Topcon TRC-50DX; fundus photo:
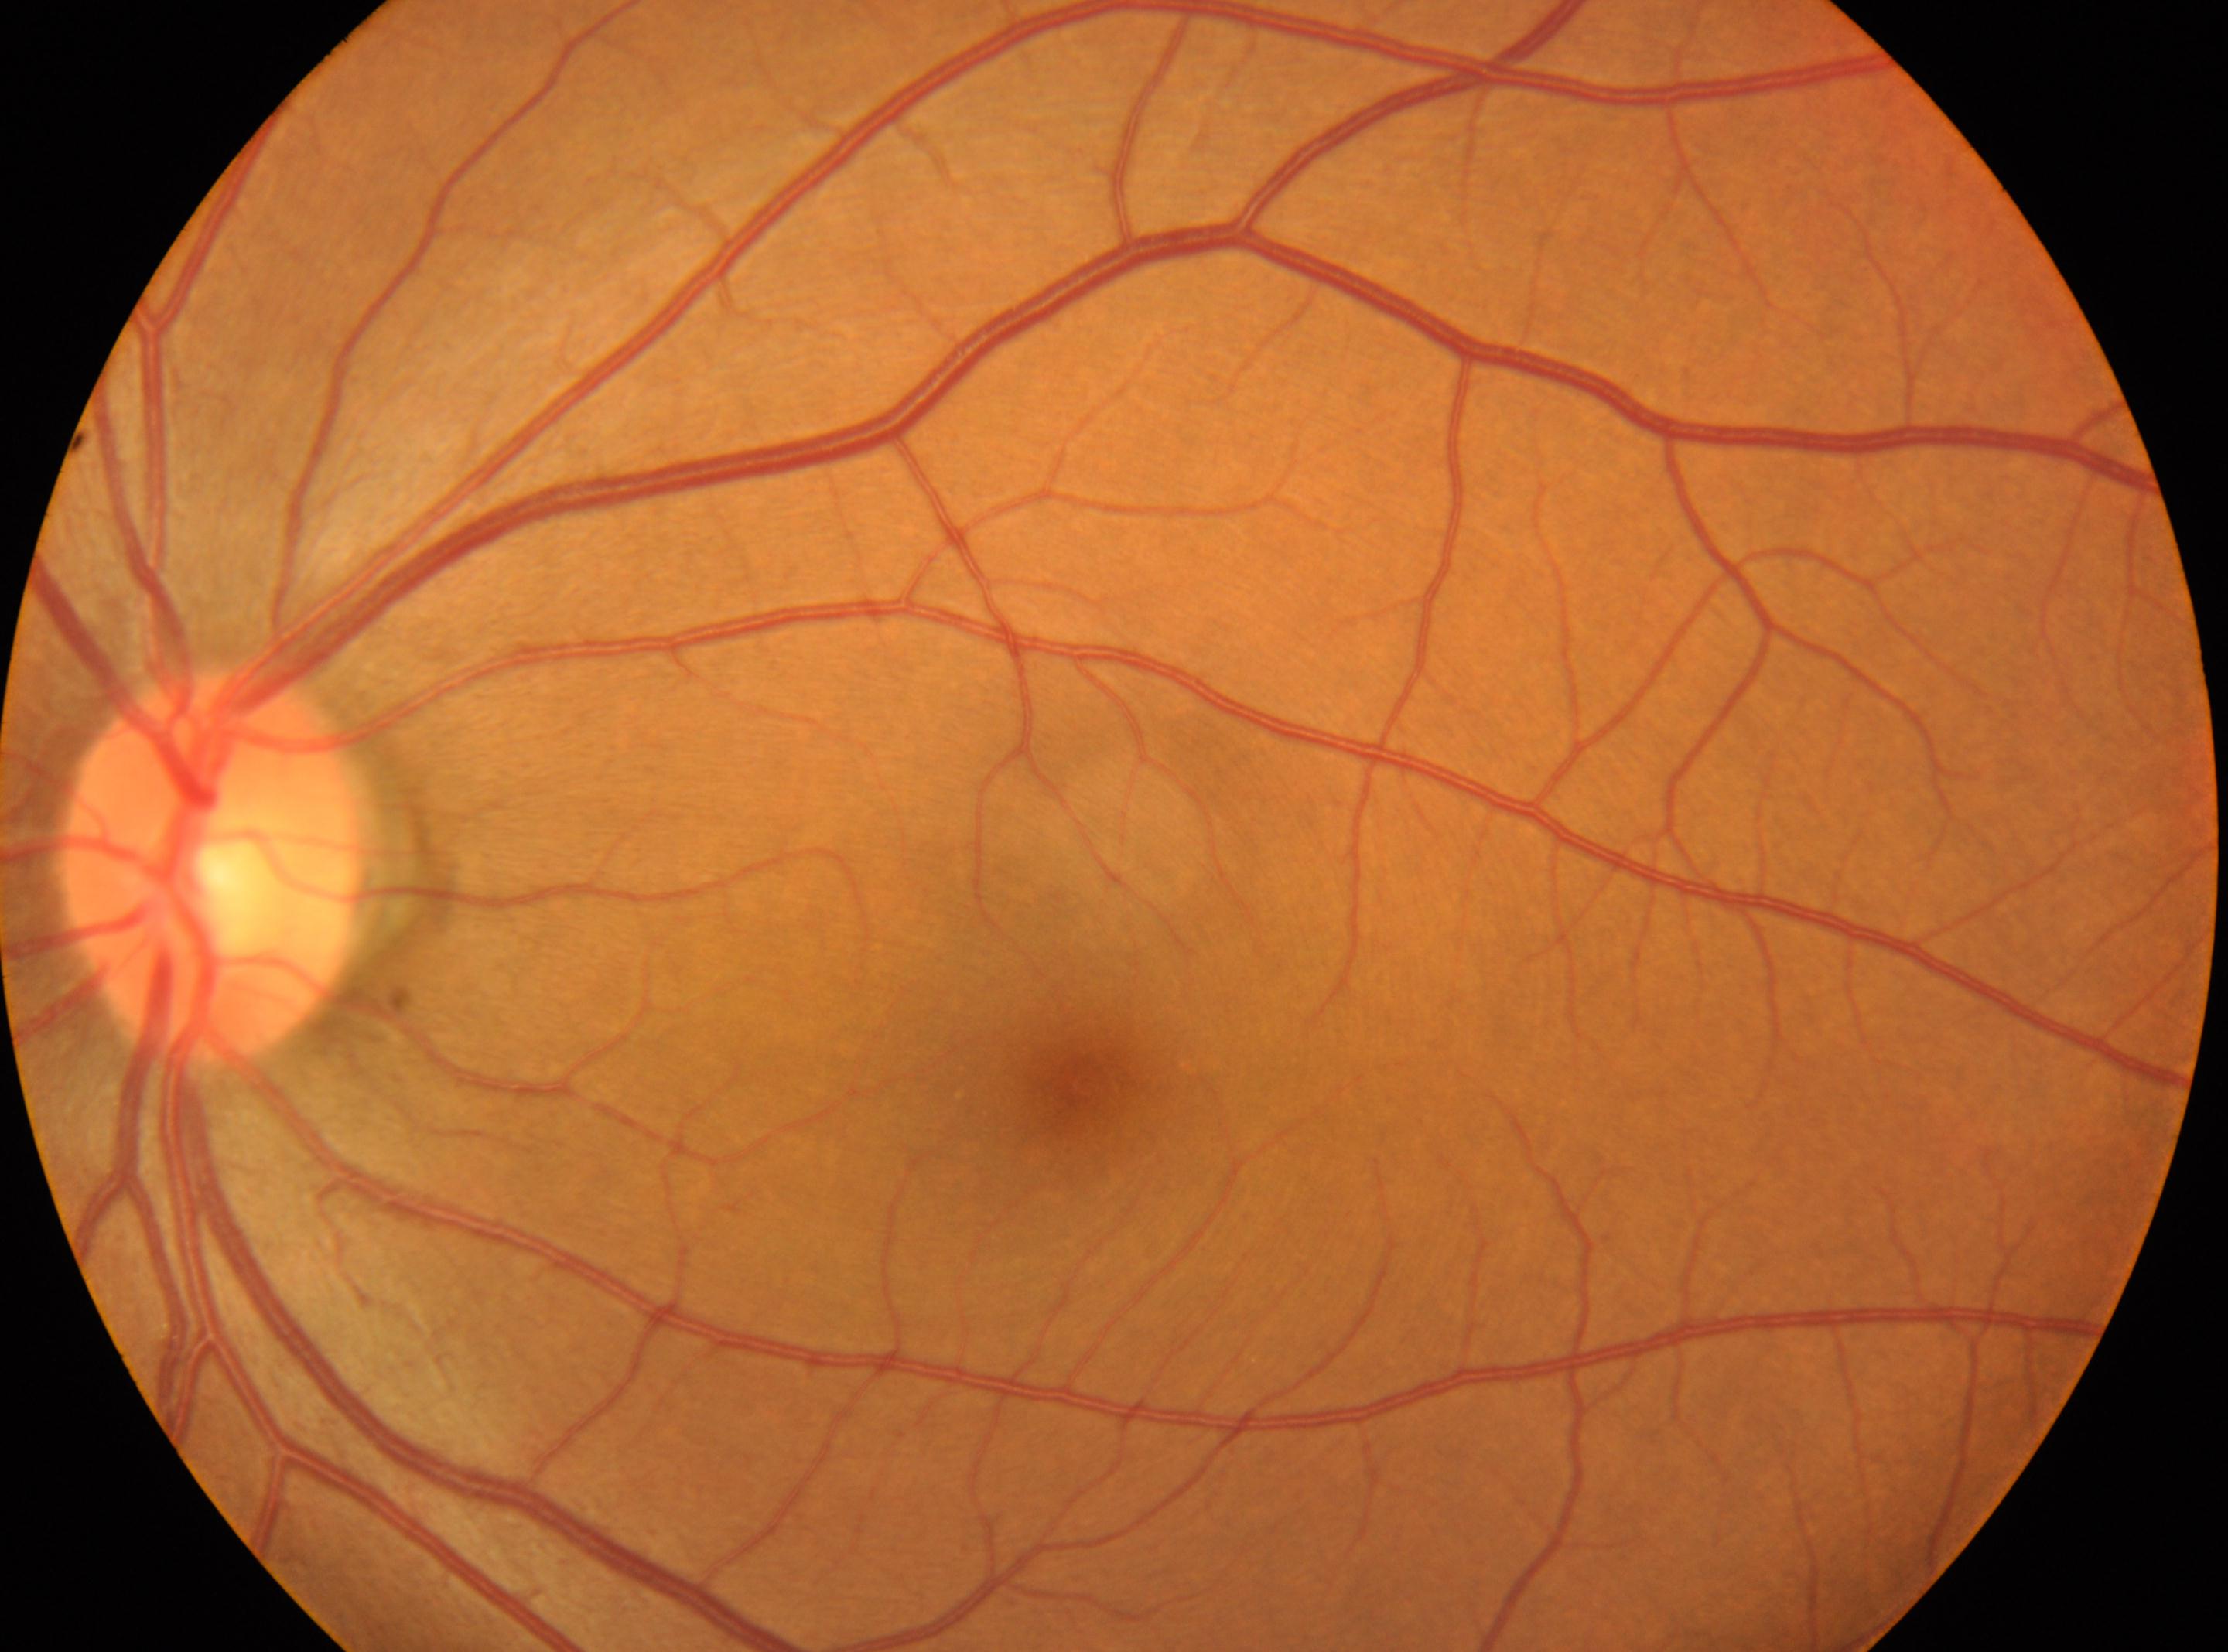
Q: Optic disc center?
A: (214,864)
Q: Where is the fovea?
A: (1085,1083)
Q: DR stage?
A: no apparent retinopathy (grade 0)
Q: Which eye is imaged?
A: left